Acquired with a Topcon TRC-50DX
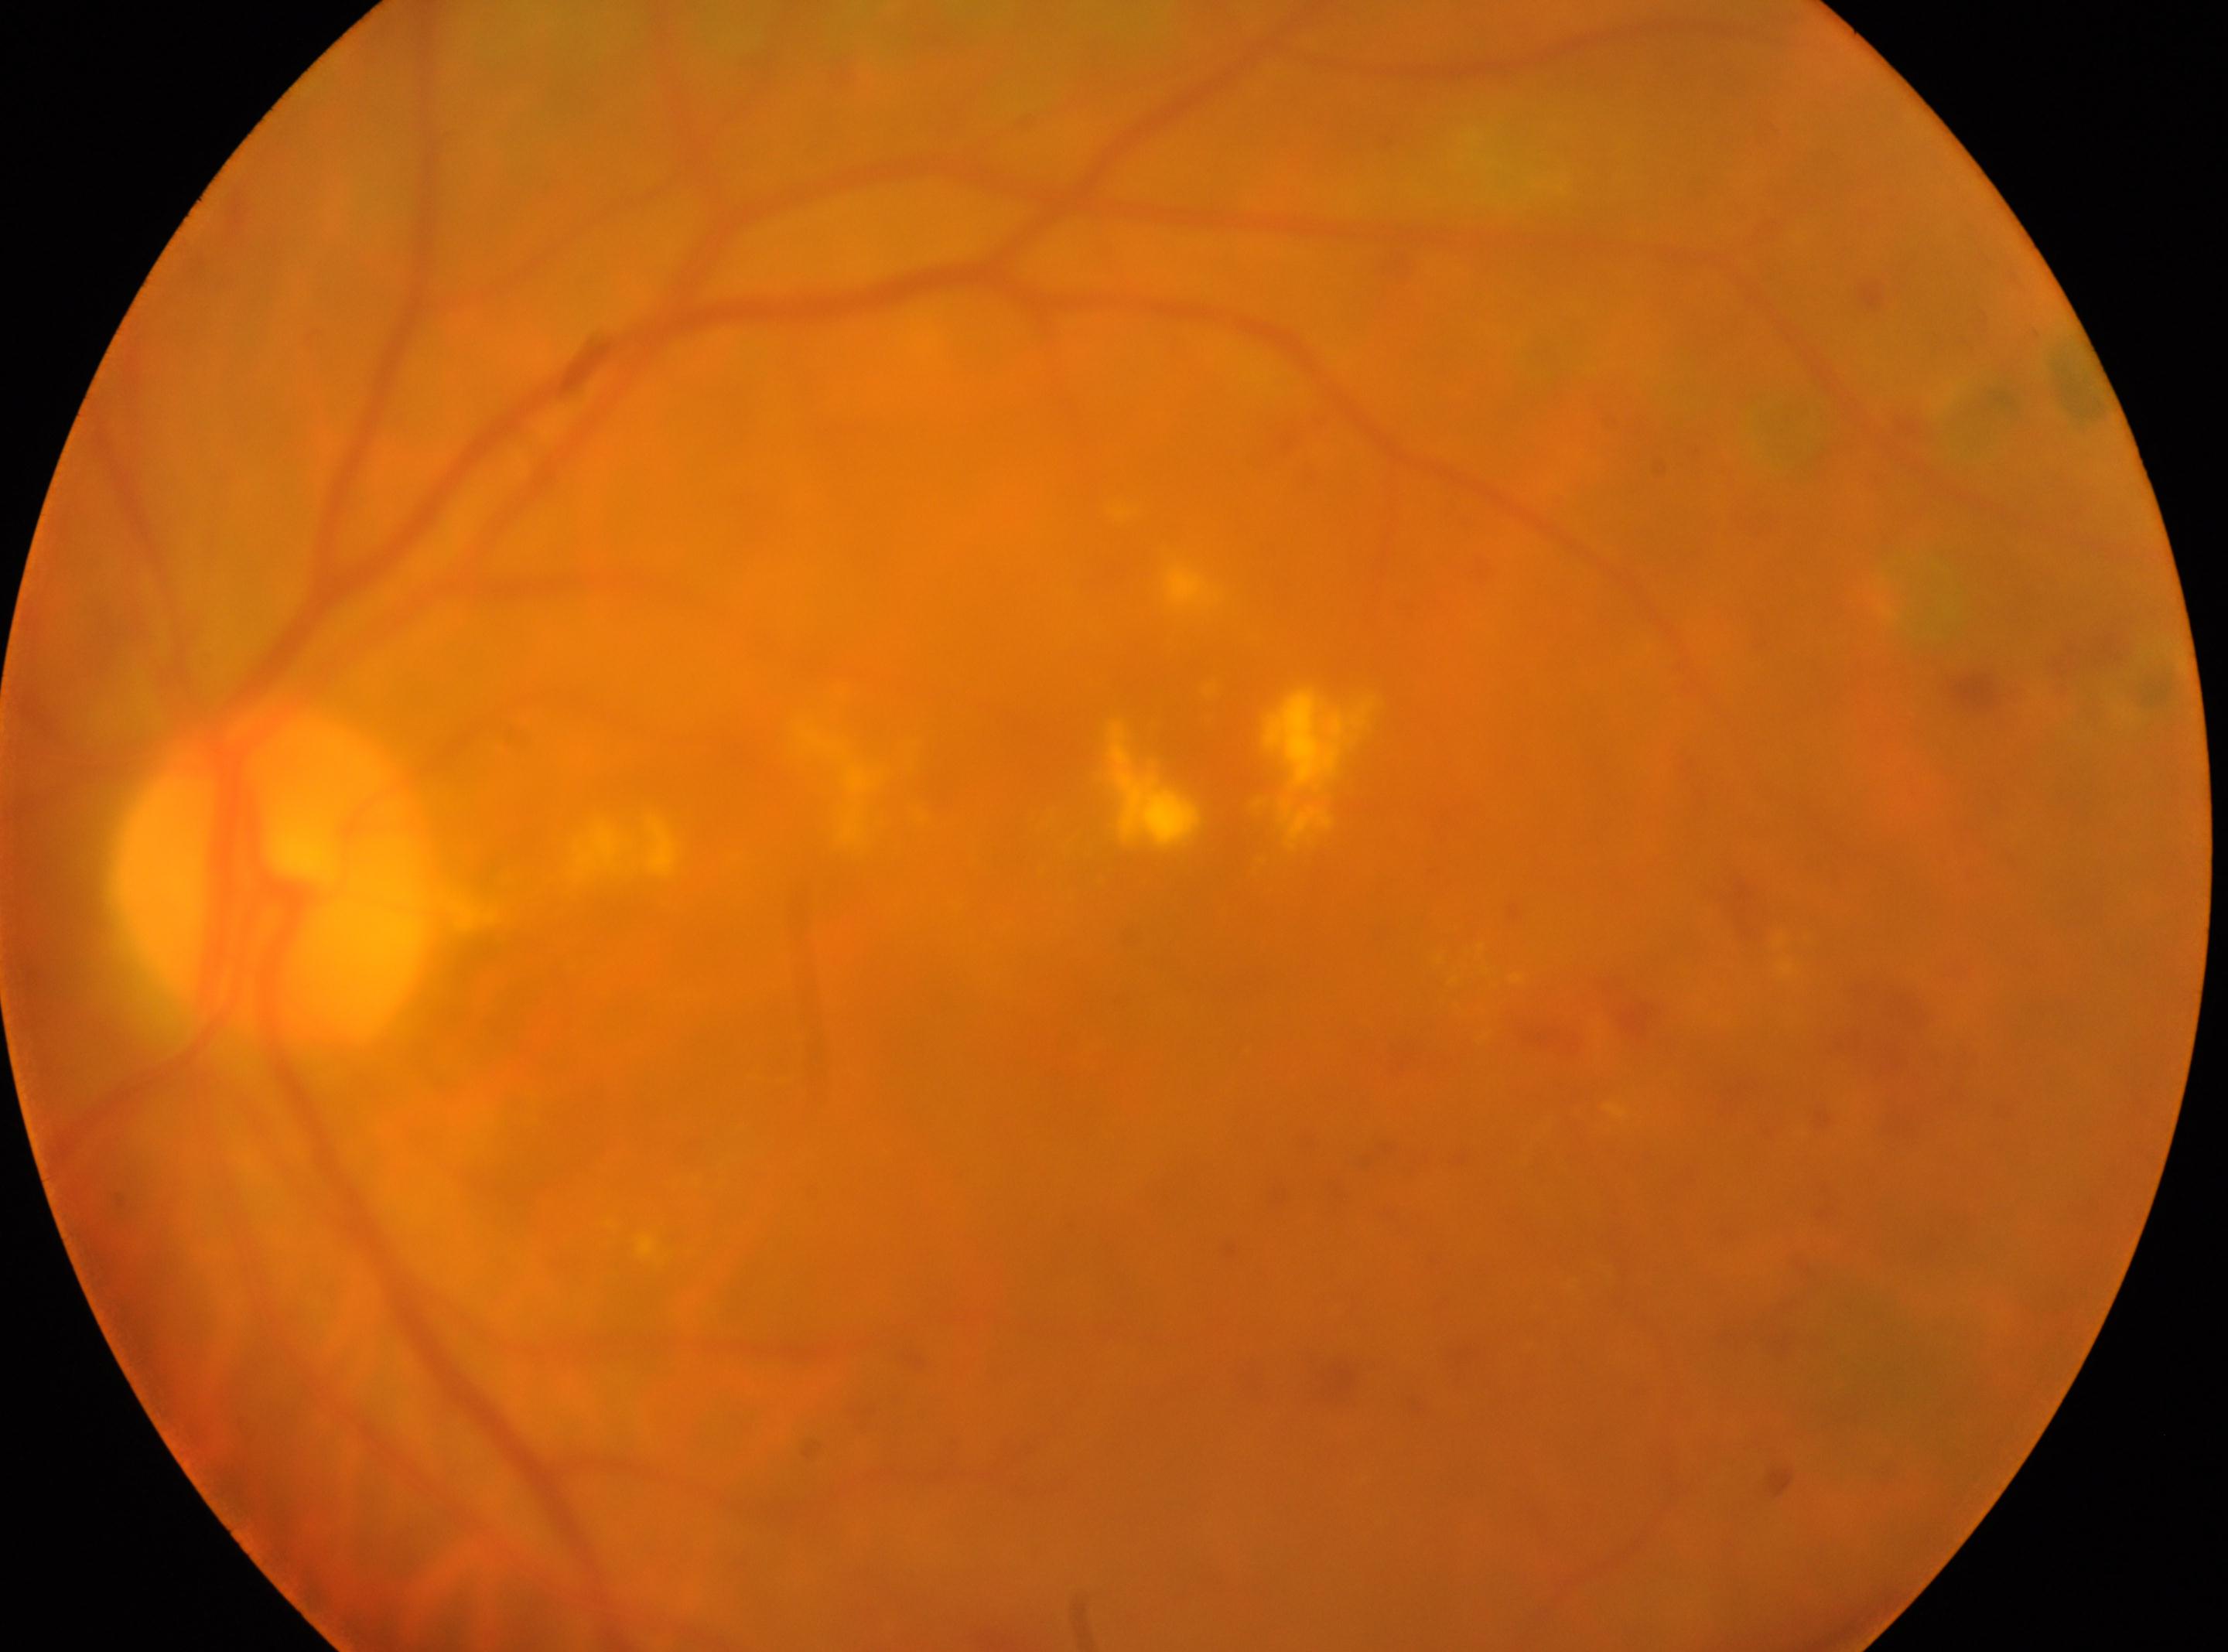 Diabetic retinopathy (DR) is laser-treated DR. The foveal center is at 1156px, 973px. The disc center is at 272px, 875px. Eye: OS.